1932 x 1932 pixels. 45-degree field of view. Color fundus image
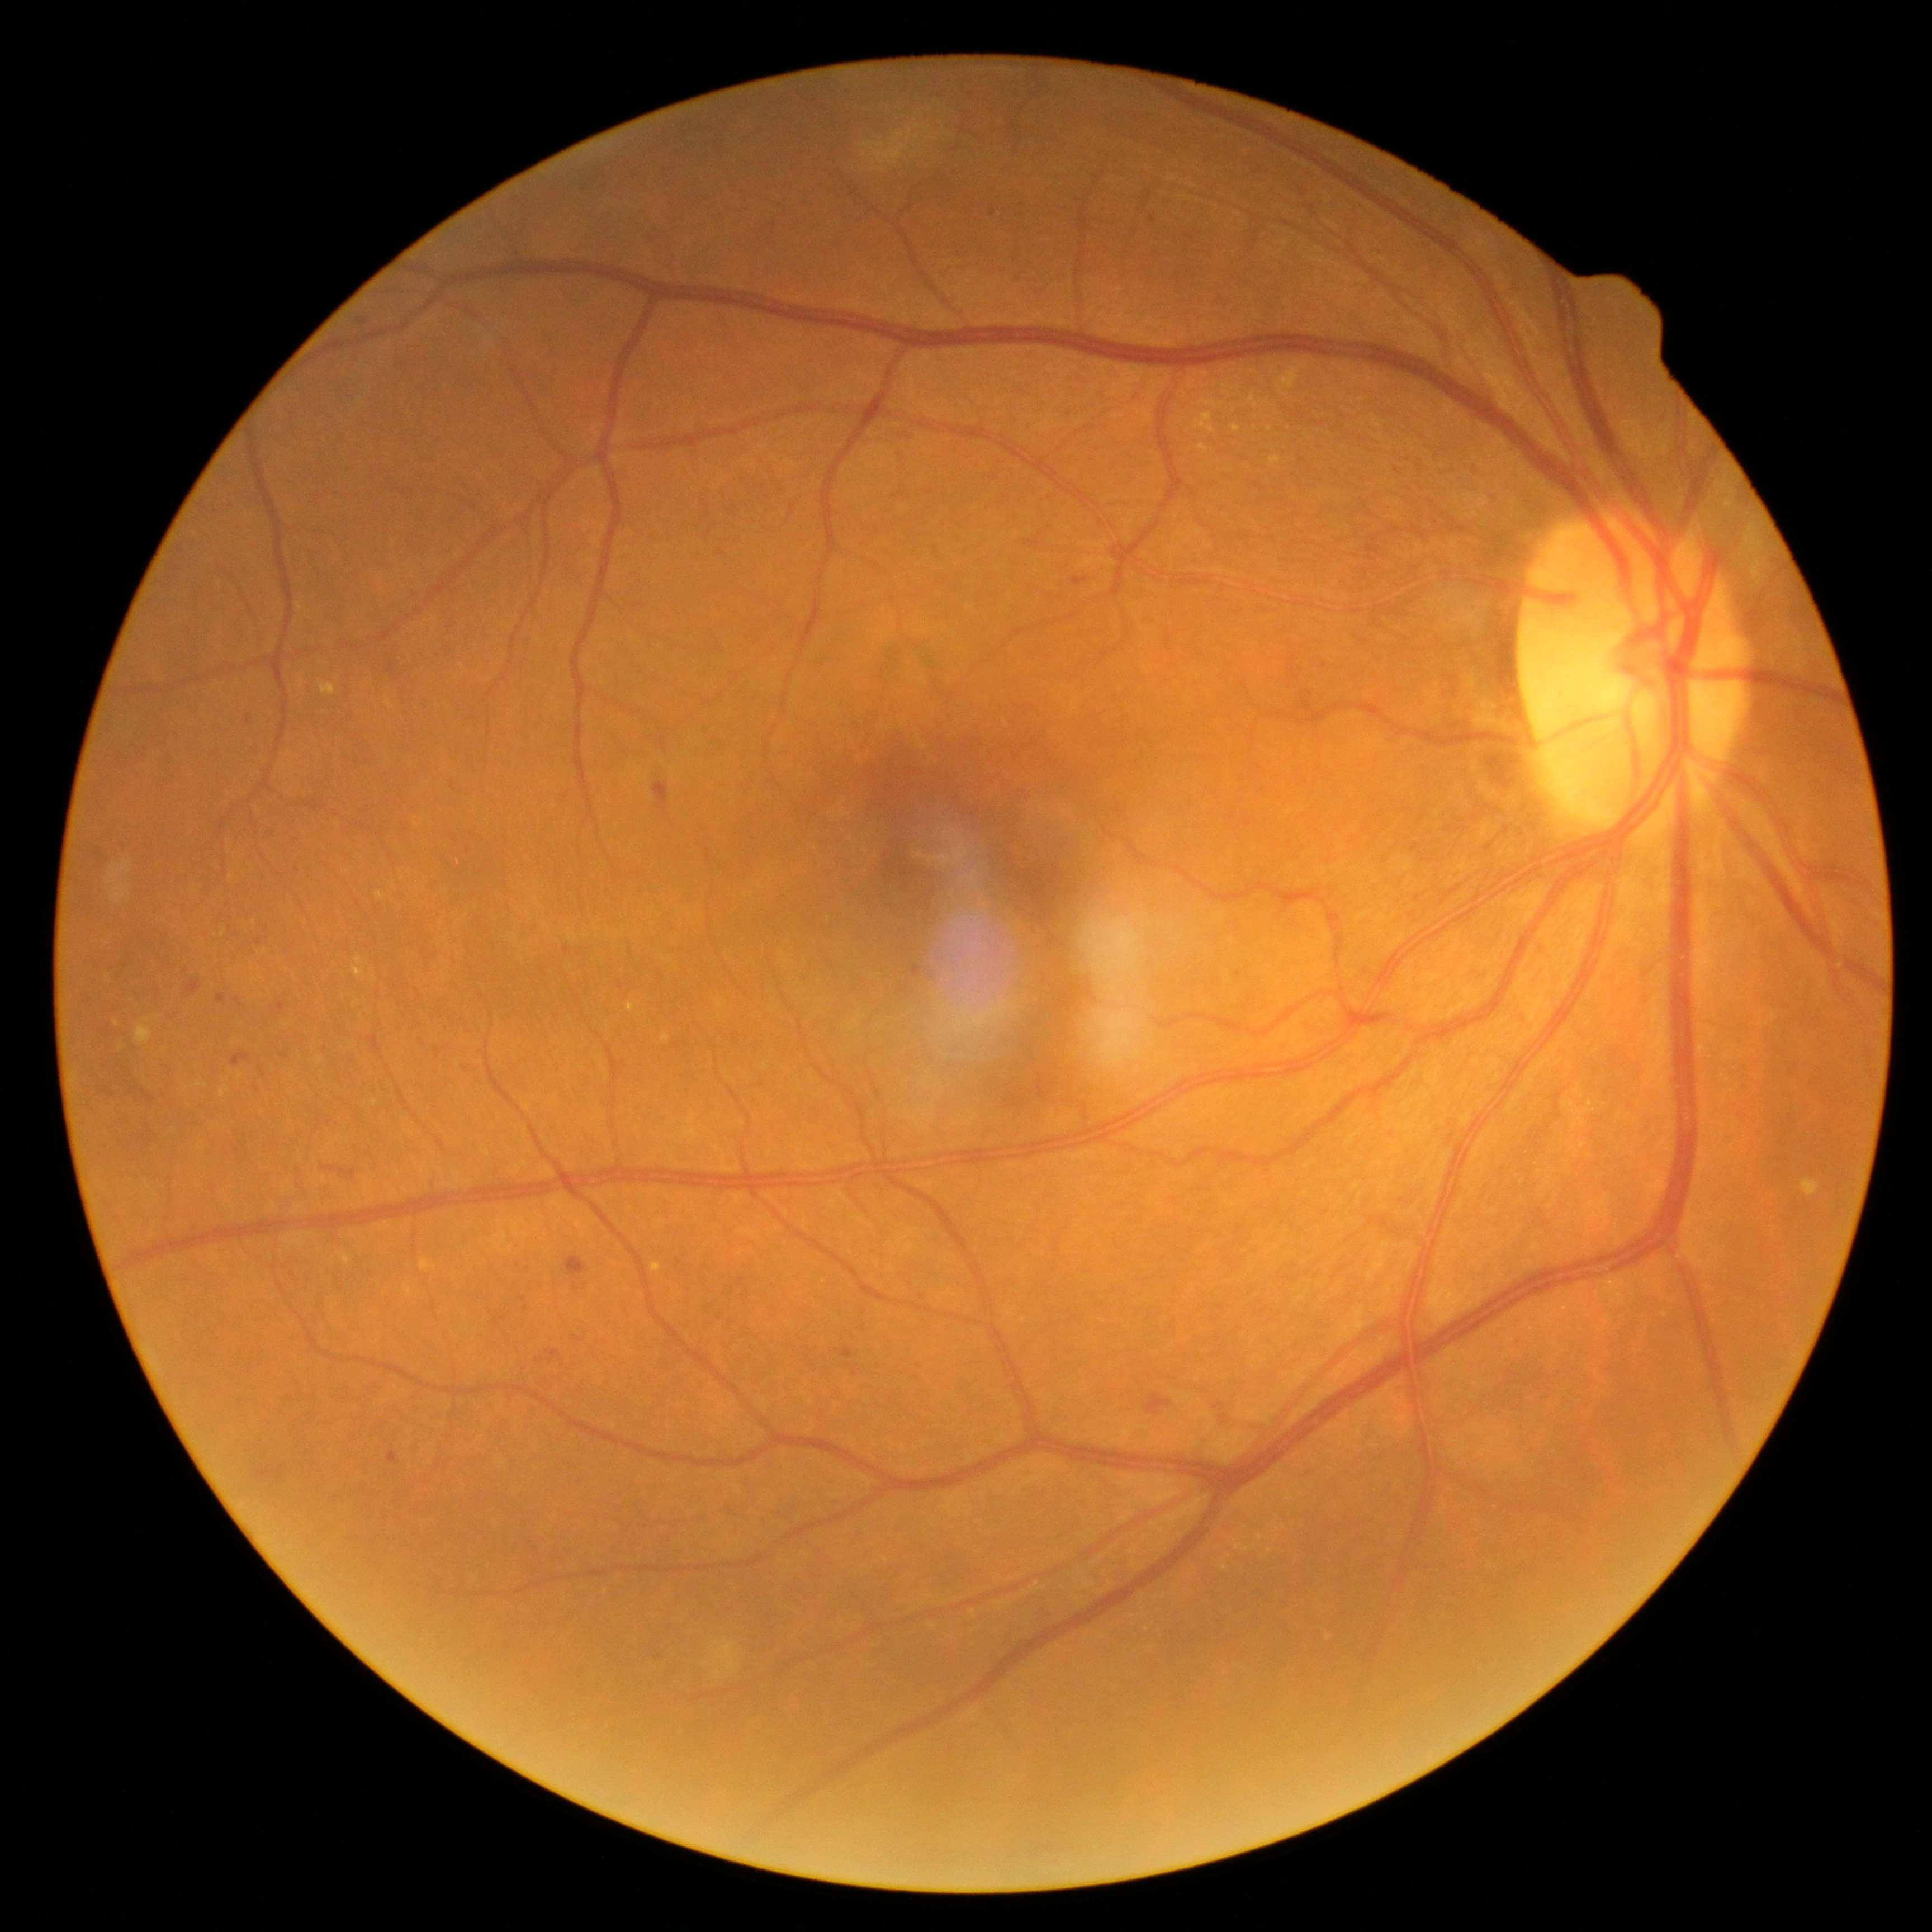 Diabetic retinopathy (DR): grade 2 (moderate NPDR); non-proliferative diabetic retinopathy
Representative lesions:
• soft exudates (SEs): none
• hard exudates (EXs) (partial): [354,969,366,979]; [219,1088,228,1097]; [319,683,336,697]; [1235,1543,1252,1554]; [1201,373,1210,376]; [1257,1533,1266,1542]; [1201,400,1235,414]; [355,958,364,964]; [1276,362,1305,391]; [1232,424,1243,434]
• EXs (small, approximate centers) near <pt>1225,1568</pt>; <pt>1193,385</pt>; <pt>1270,429</pt>; <pt>1227,386</pt>; <pt>1256,416</pt>
• microaneurysms (MAs) (partial): [841,1348,856,1360]; [235,999,244,1006]; [277,1002,286,1011]; [912,967,922,978]; [231,1055,251,1067]; [281,1053,289,1058]; [216,993,228,1006]
• MAs (small, approximate centers) near <pt>581,892</pt>; <pt>466,1068</pt>; <pt>505,1319</pt>; <pt>538,1362</pt>; <pt>924,1297</pt>; <pt>259,942</pt>; <pt>993,213</pt>; <pt>1152,219</pt>; <pt>126,966</pt>
• hemorrhages (HEs): [1299,695,1314,711]; [1143,1393,1172,1416]; [278,1465,287,1475]; [655,783,668,810]; [659,736,668,752]; [257,1471,272,1481]; [323,1167,355,1179]; [567,1258,588,1276]; [1074,577,1090,586]
• HEs (small, approximate centers) near <pt>1299,694</pt>